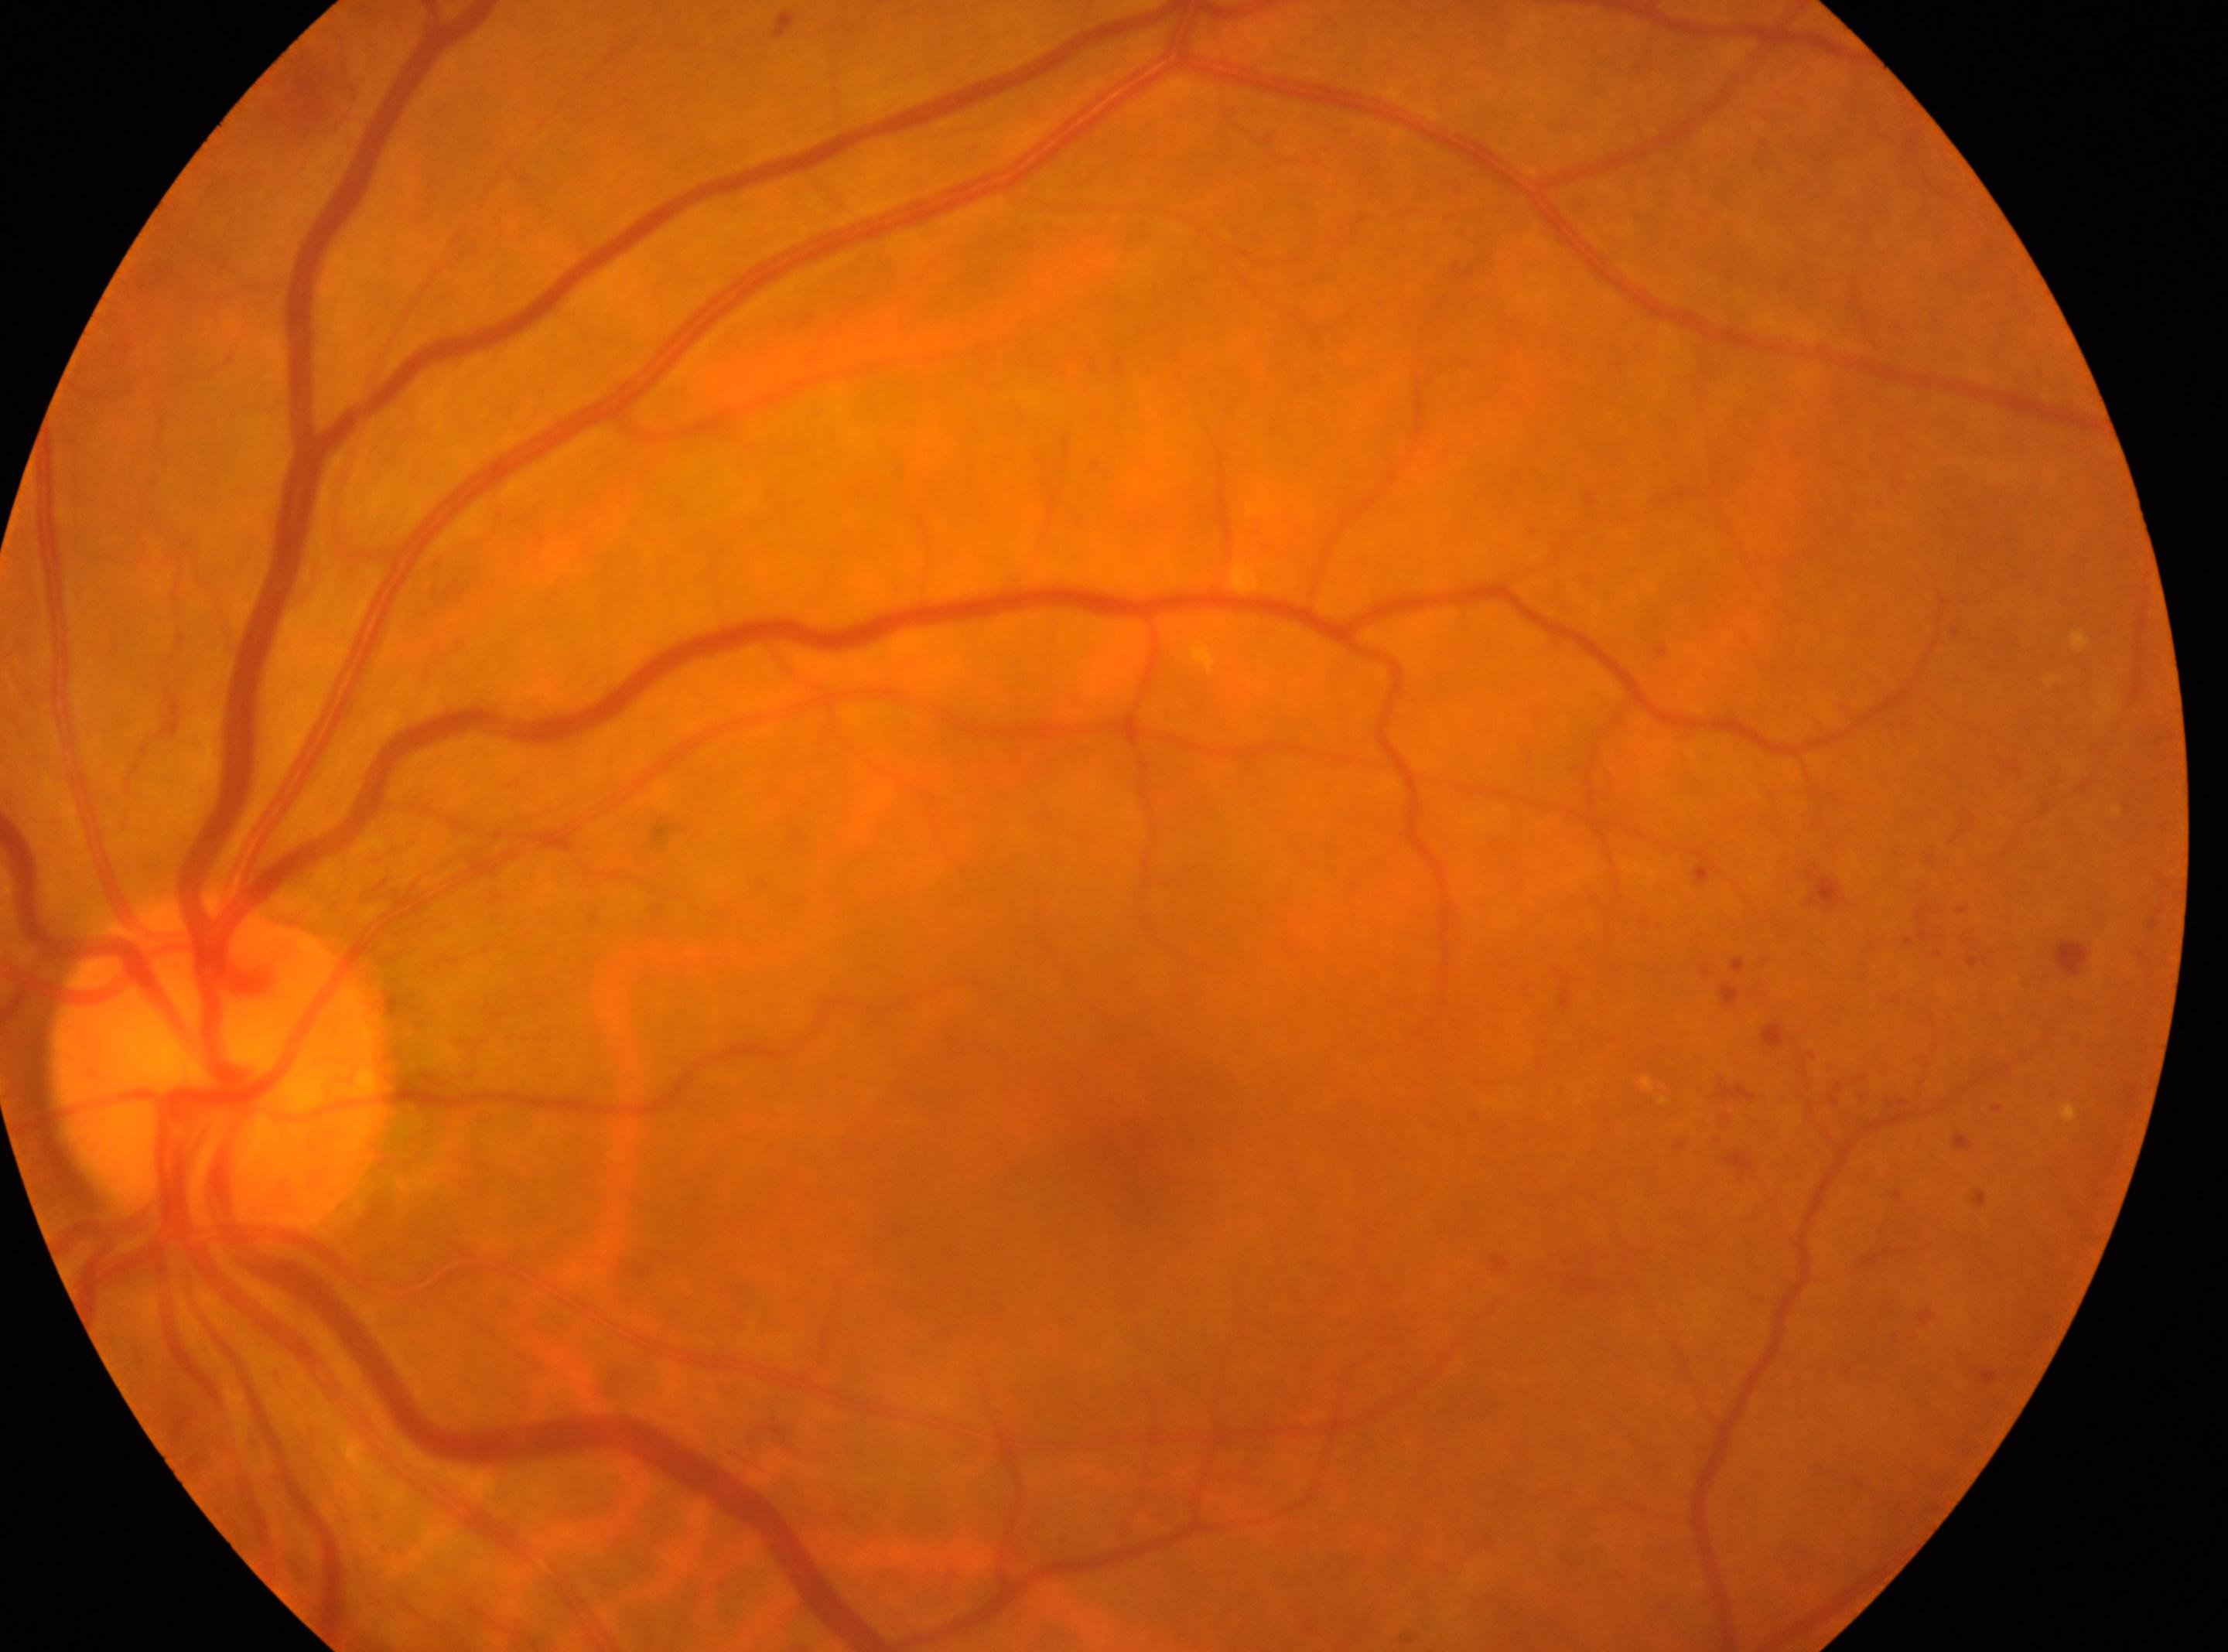

fovea centralis = (x=1134, y=1149)
diabetic retinopathy grade = 2 (moderate NPDR) — more than just microaneurysms but less than severe NPDR
optic disc center = (x=221, y=1072)
eye = OS